Color fundus photograph · FOV: 45 degrees — 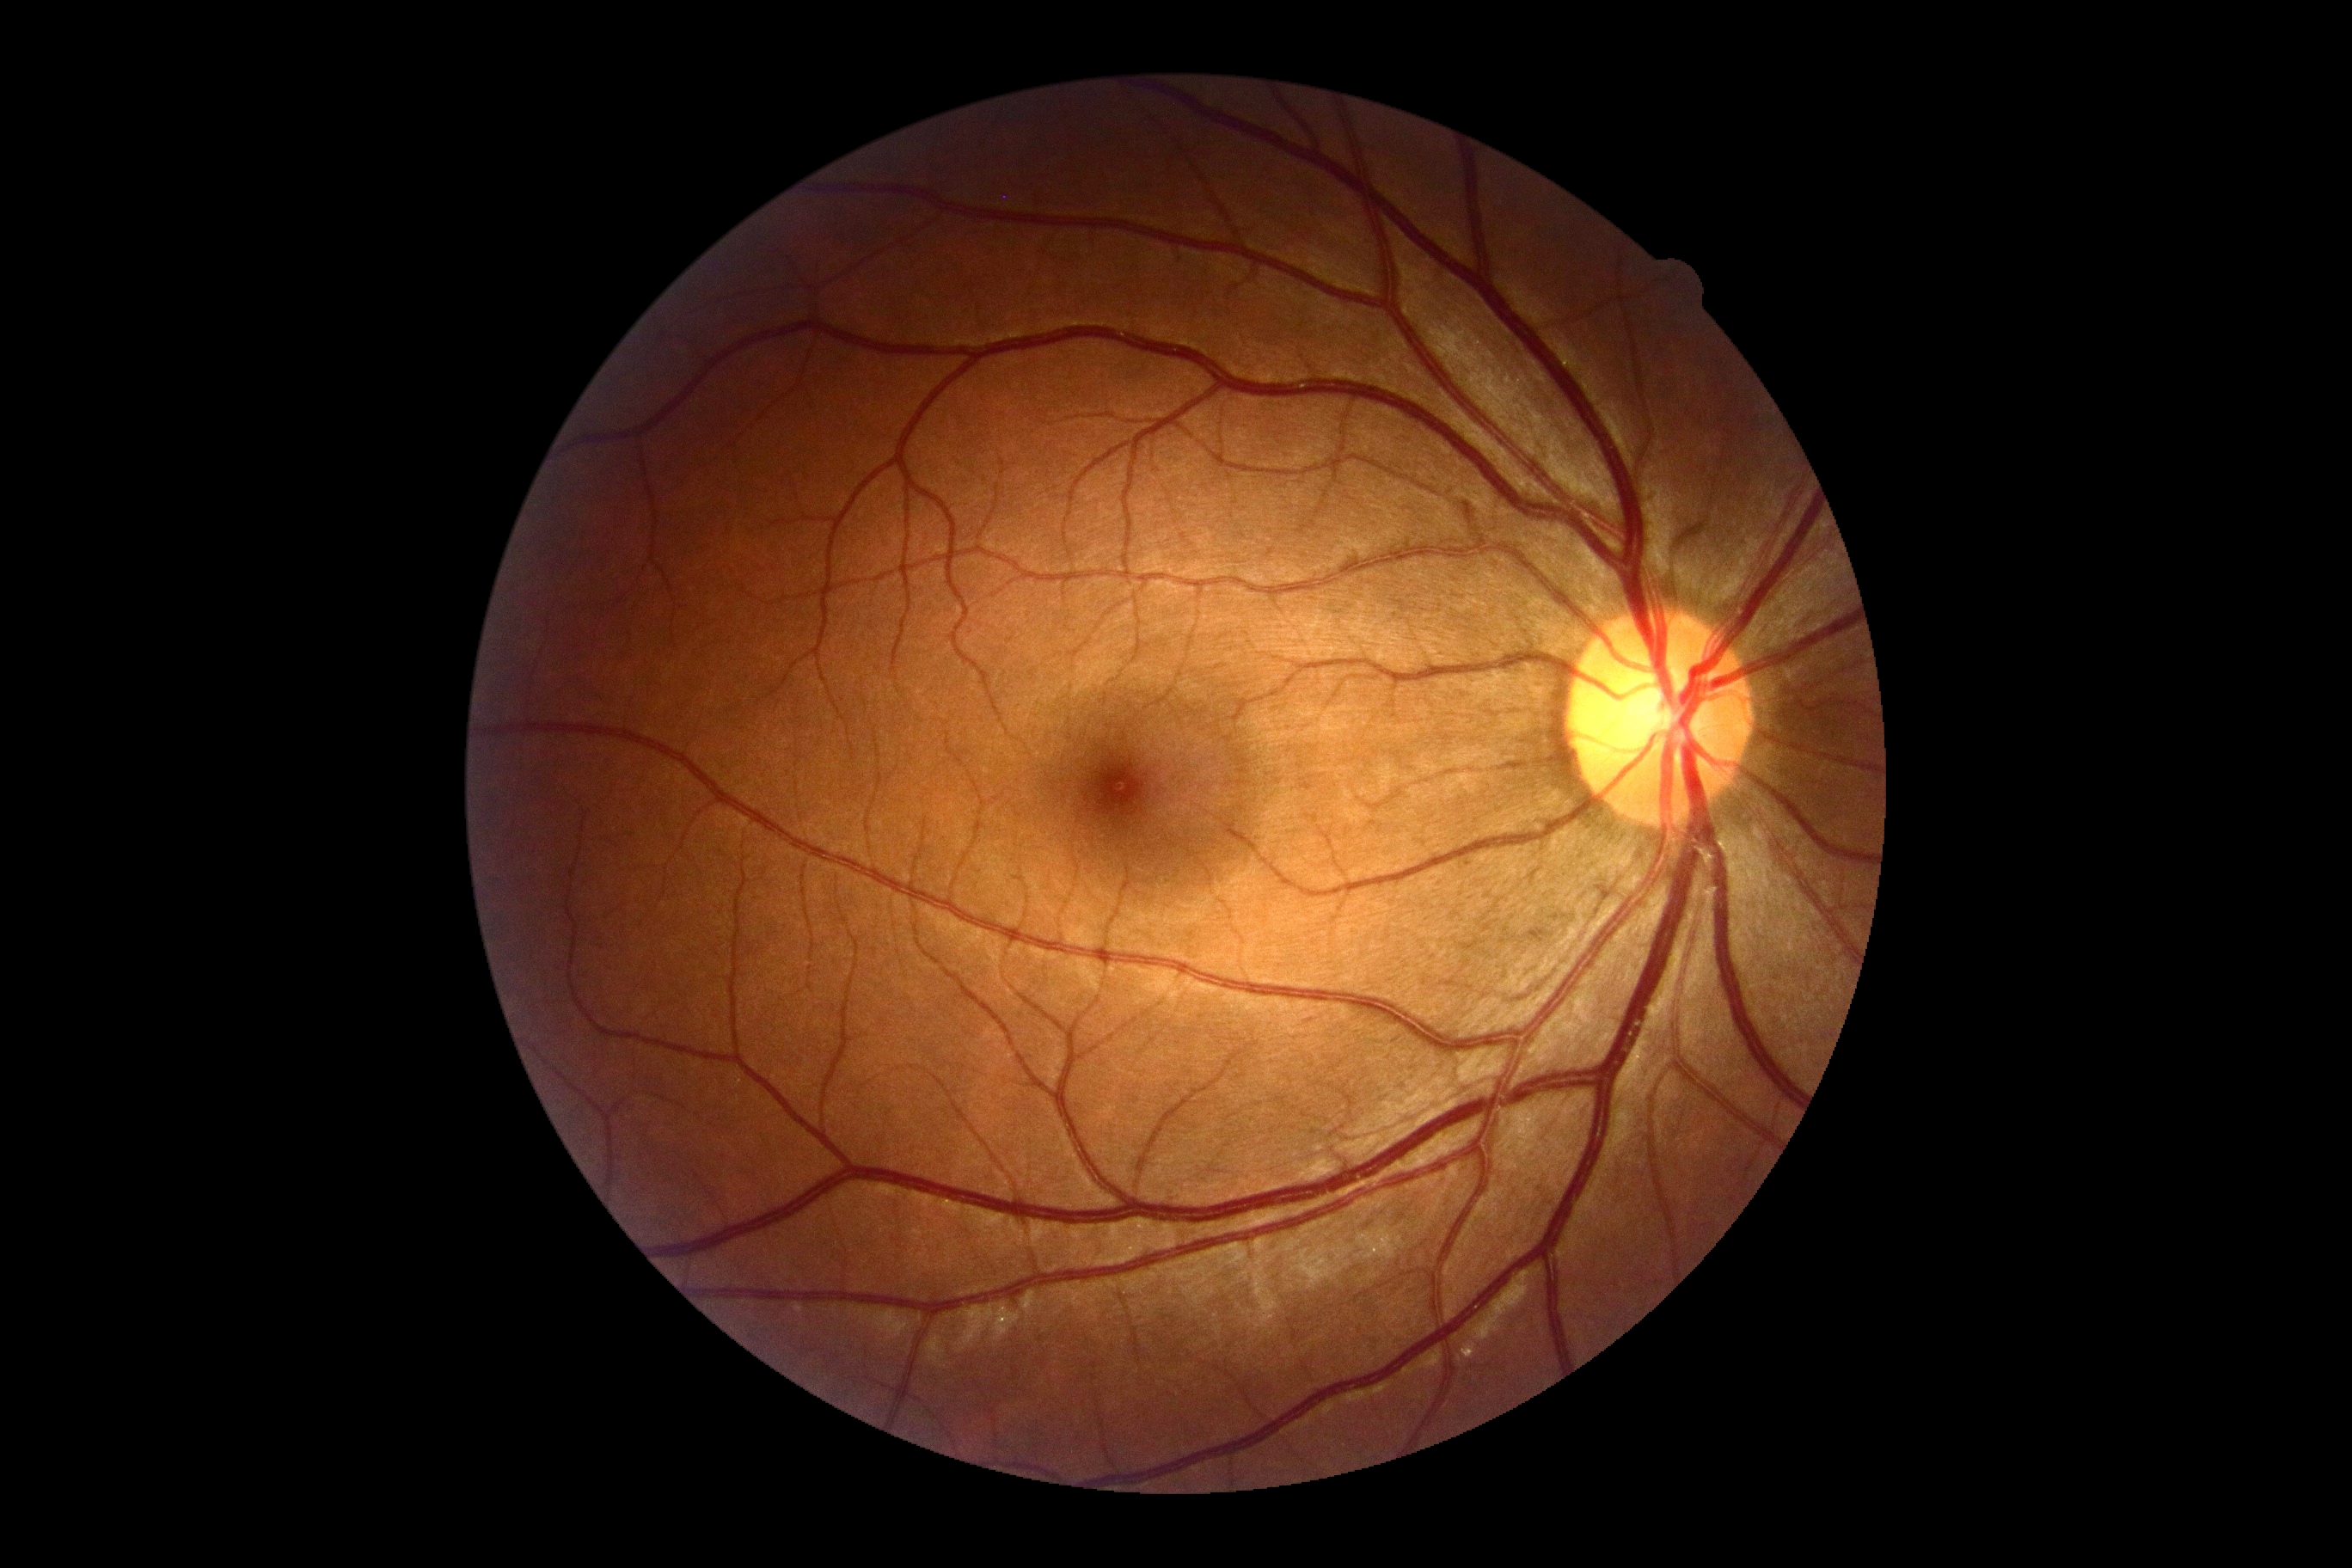

Retinopathy: grade 0.